Camera: Clarity RetCam 3 (130° FOV). RetCam wide-field infant fundus image: 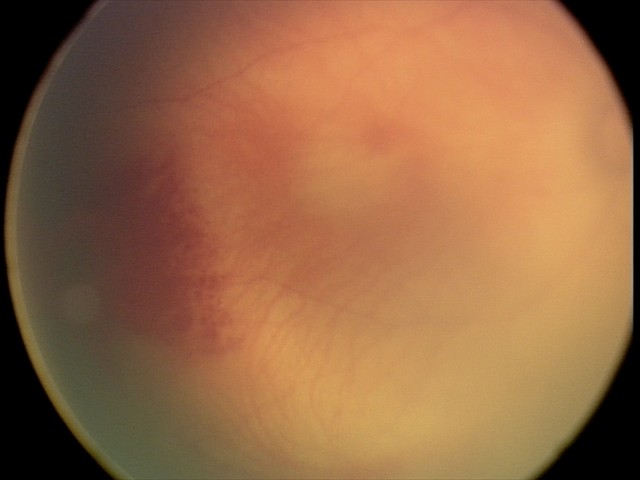
Screening examination consistent with retinal hemorrhages.